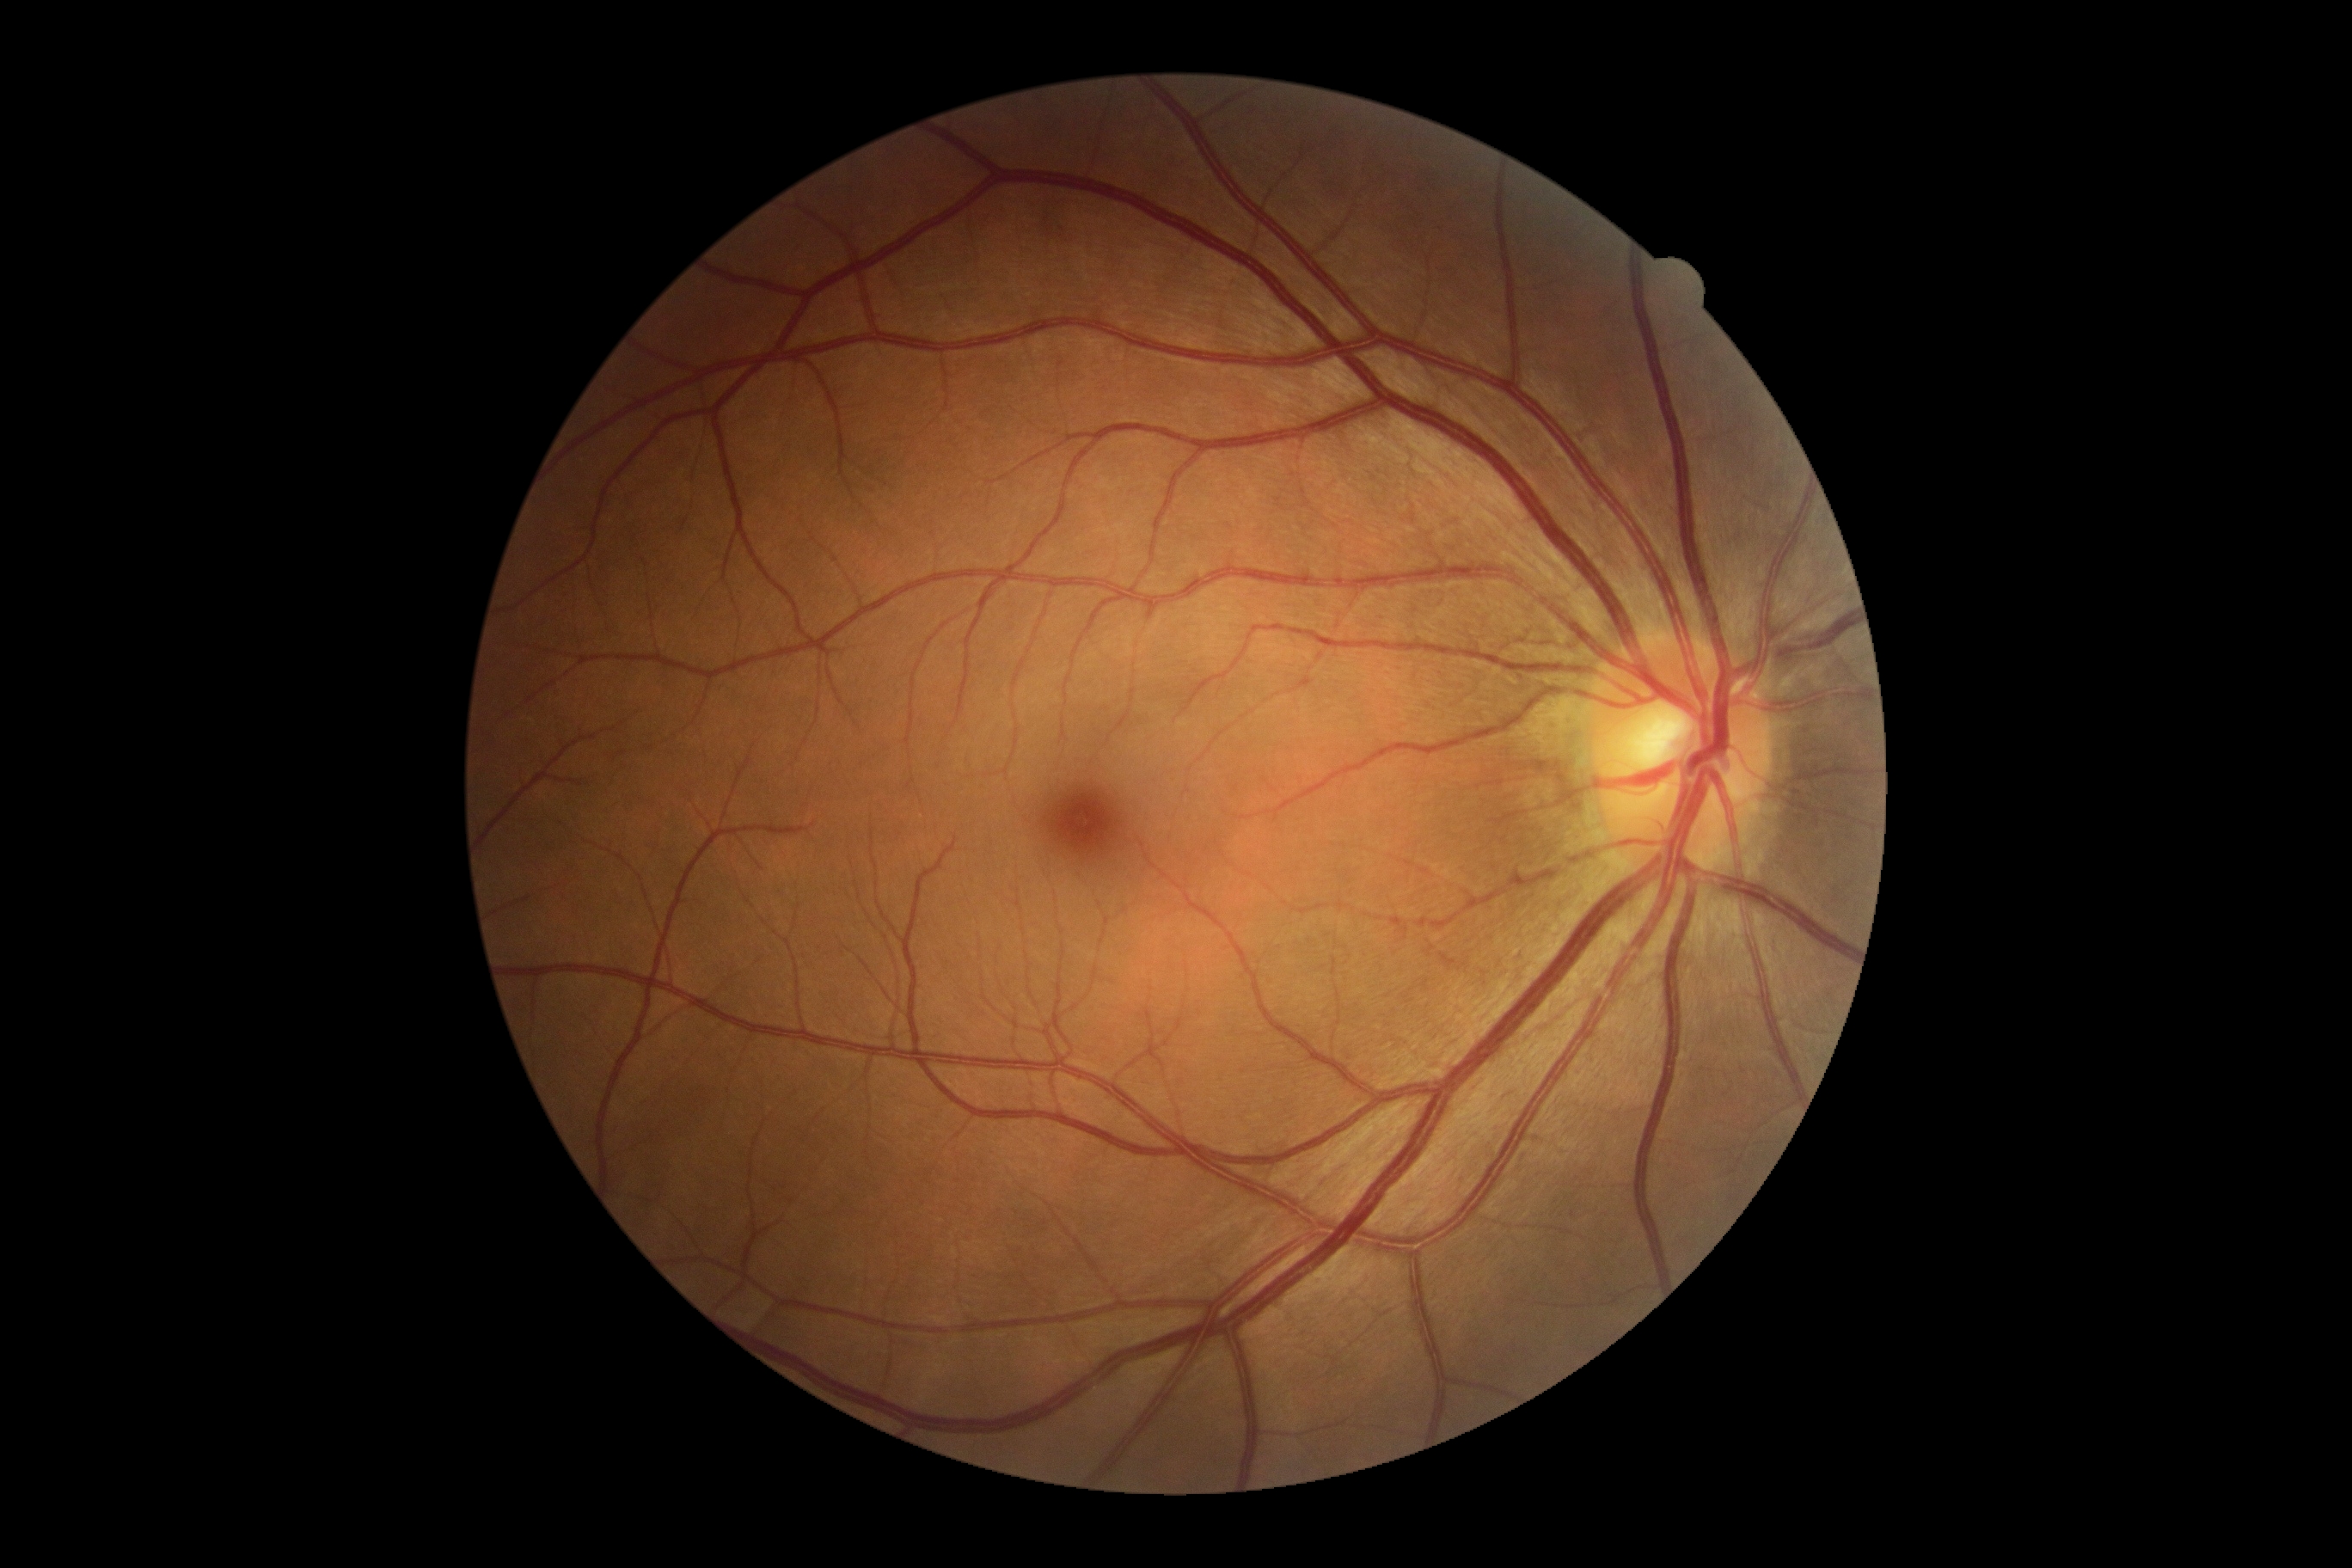 No apparent diabetic retinopathy. DR grade: 0.